2352x1568, FOV: 45 degrees, CFP:
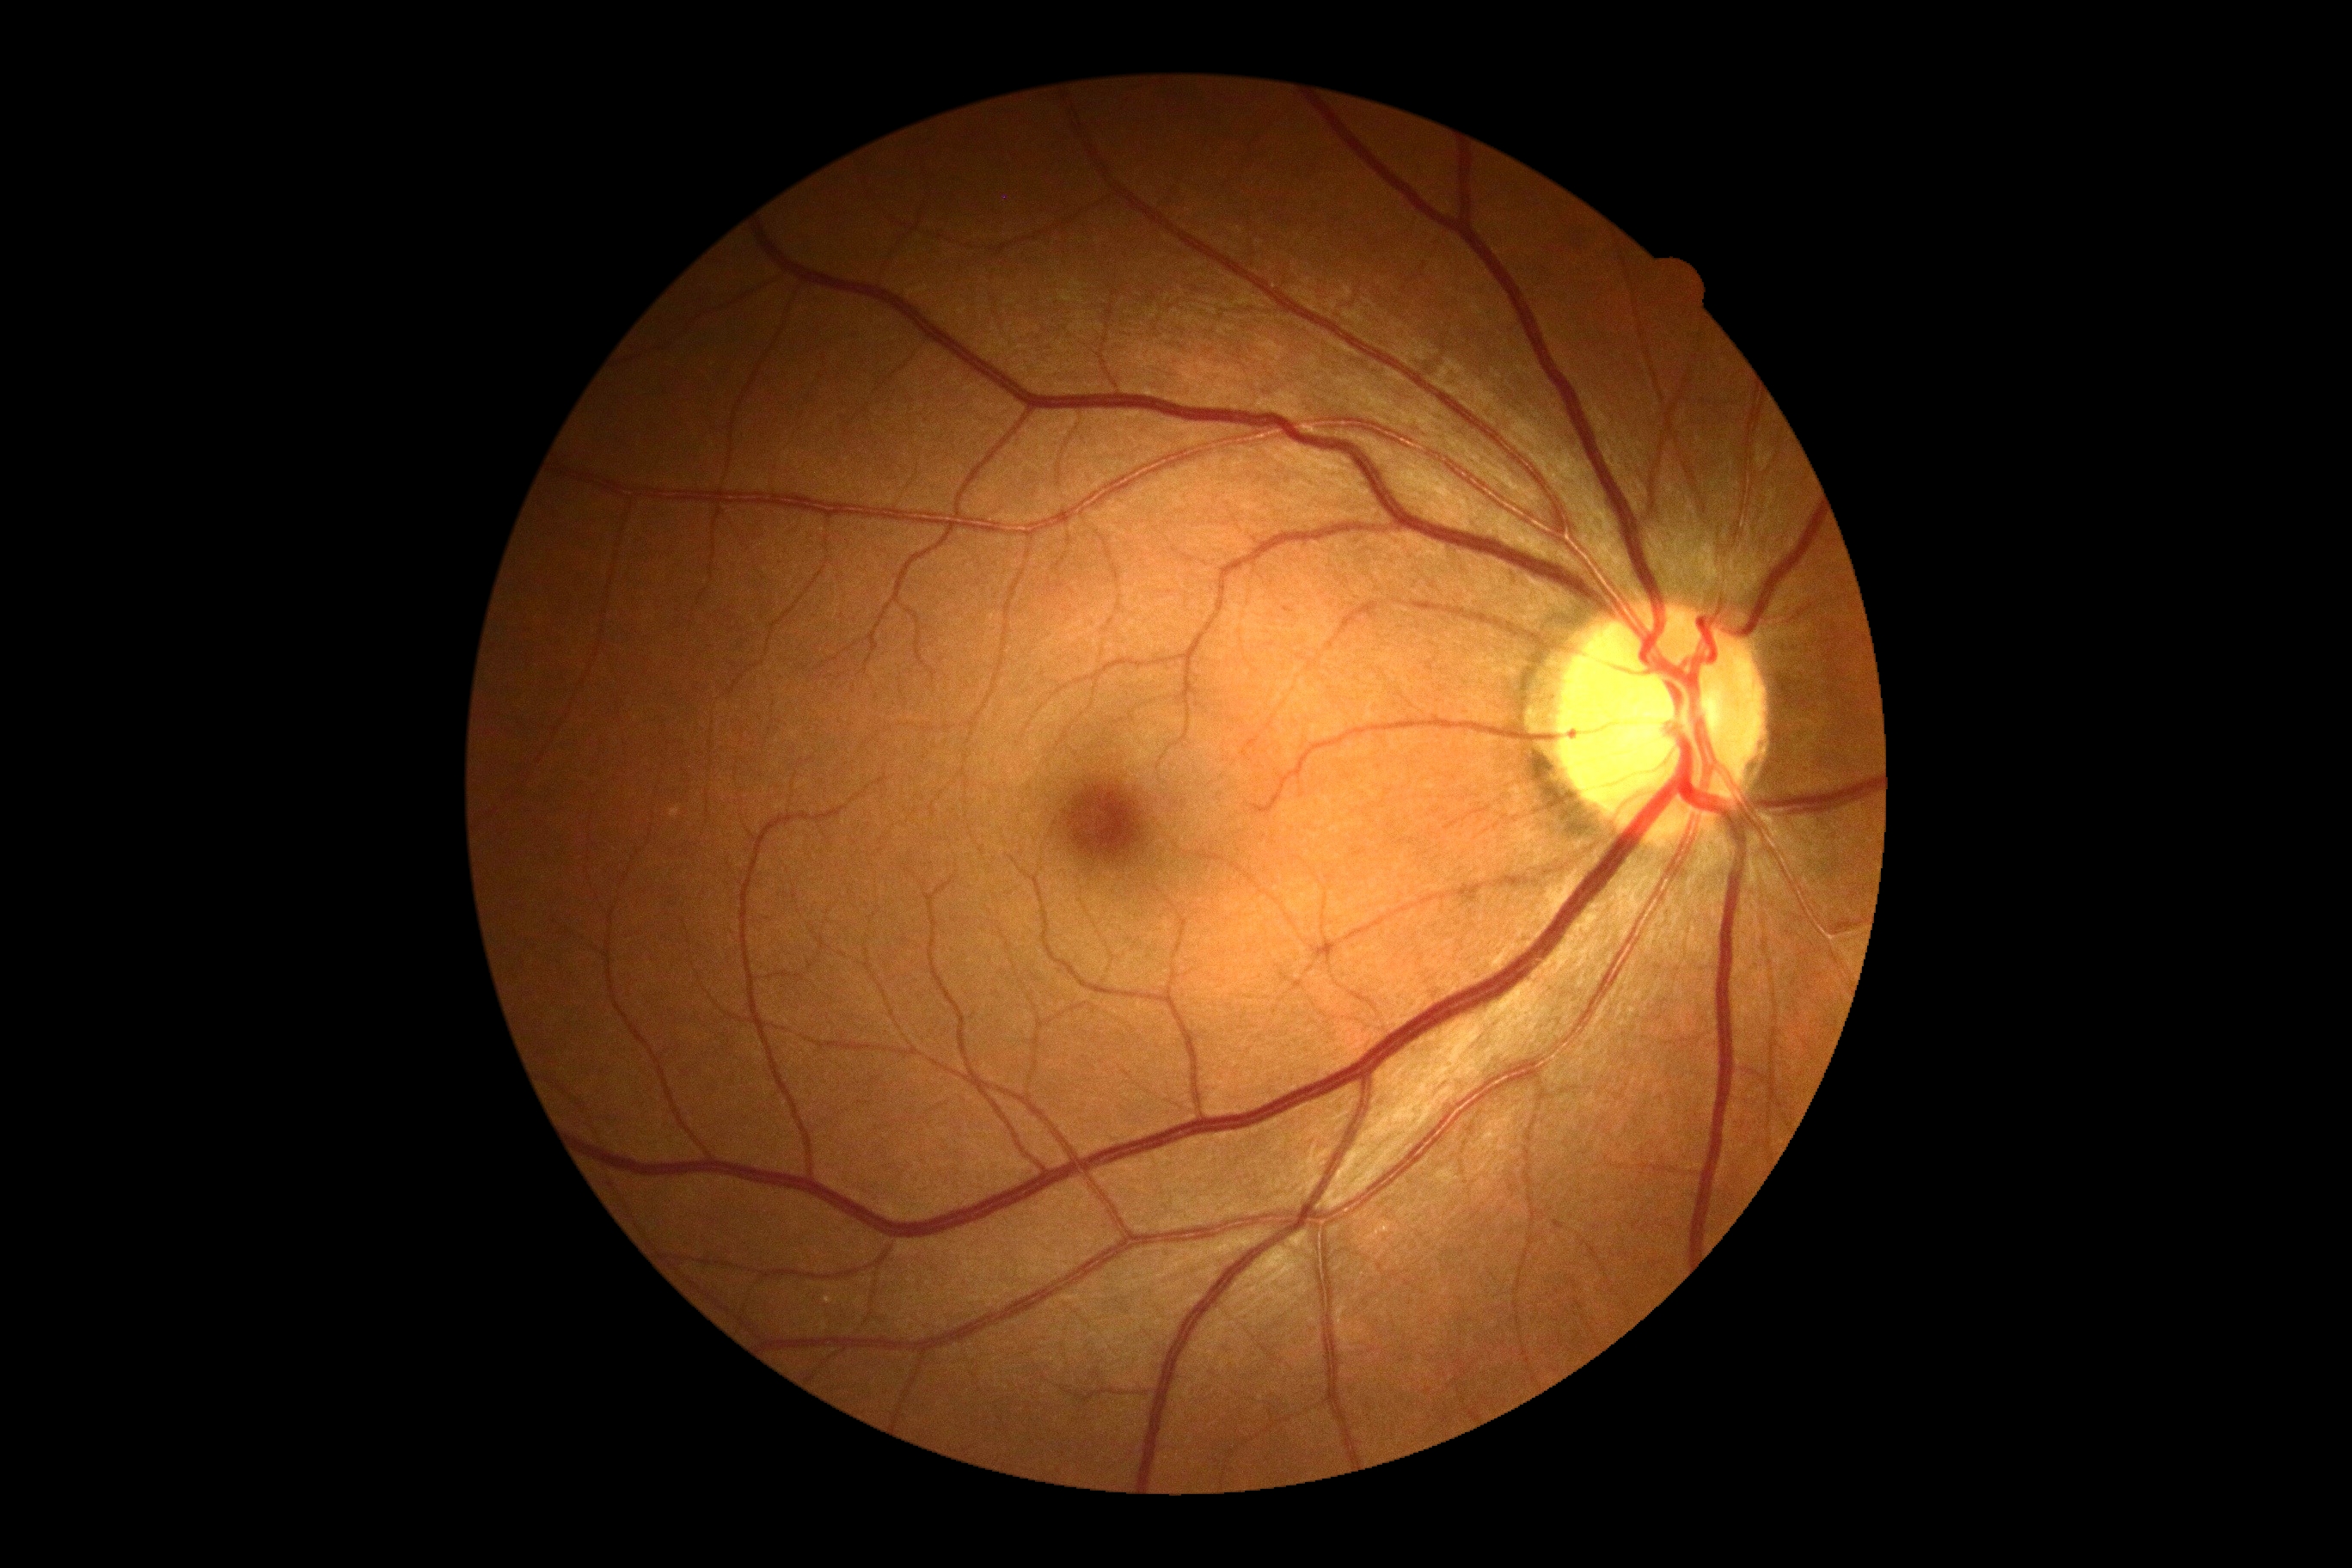 Annotations:
• DR impression — no apparent DR
• diabetic retinopathy severity — grade 0 (no apparent retinopathy) — no visible signs of diabetic retinopathy